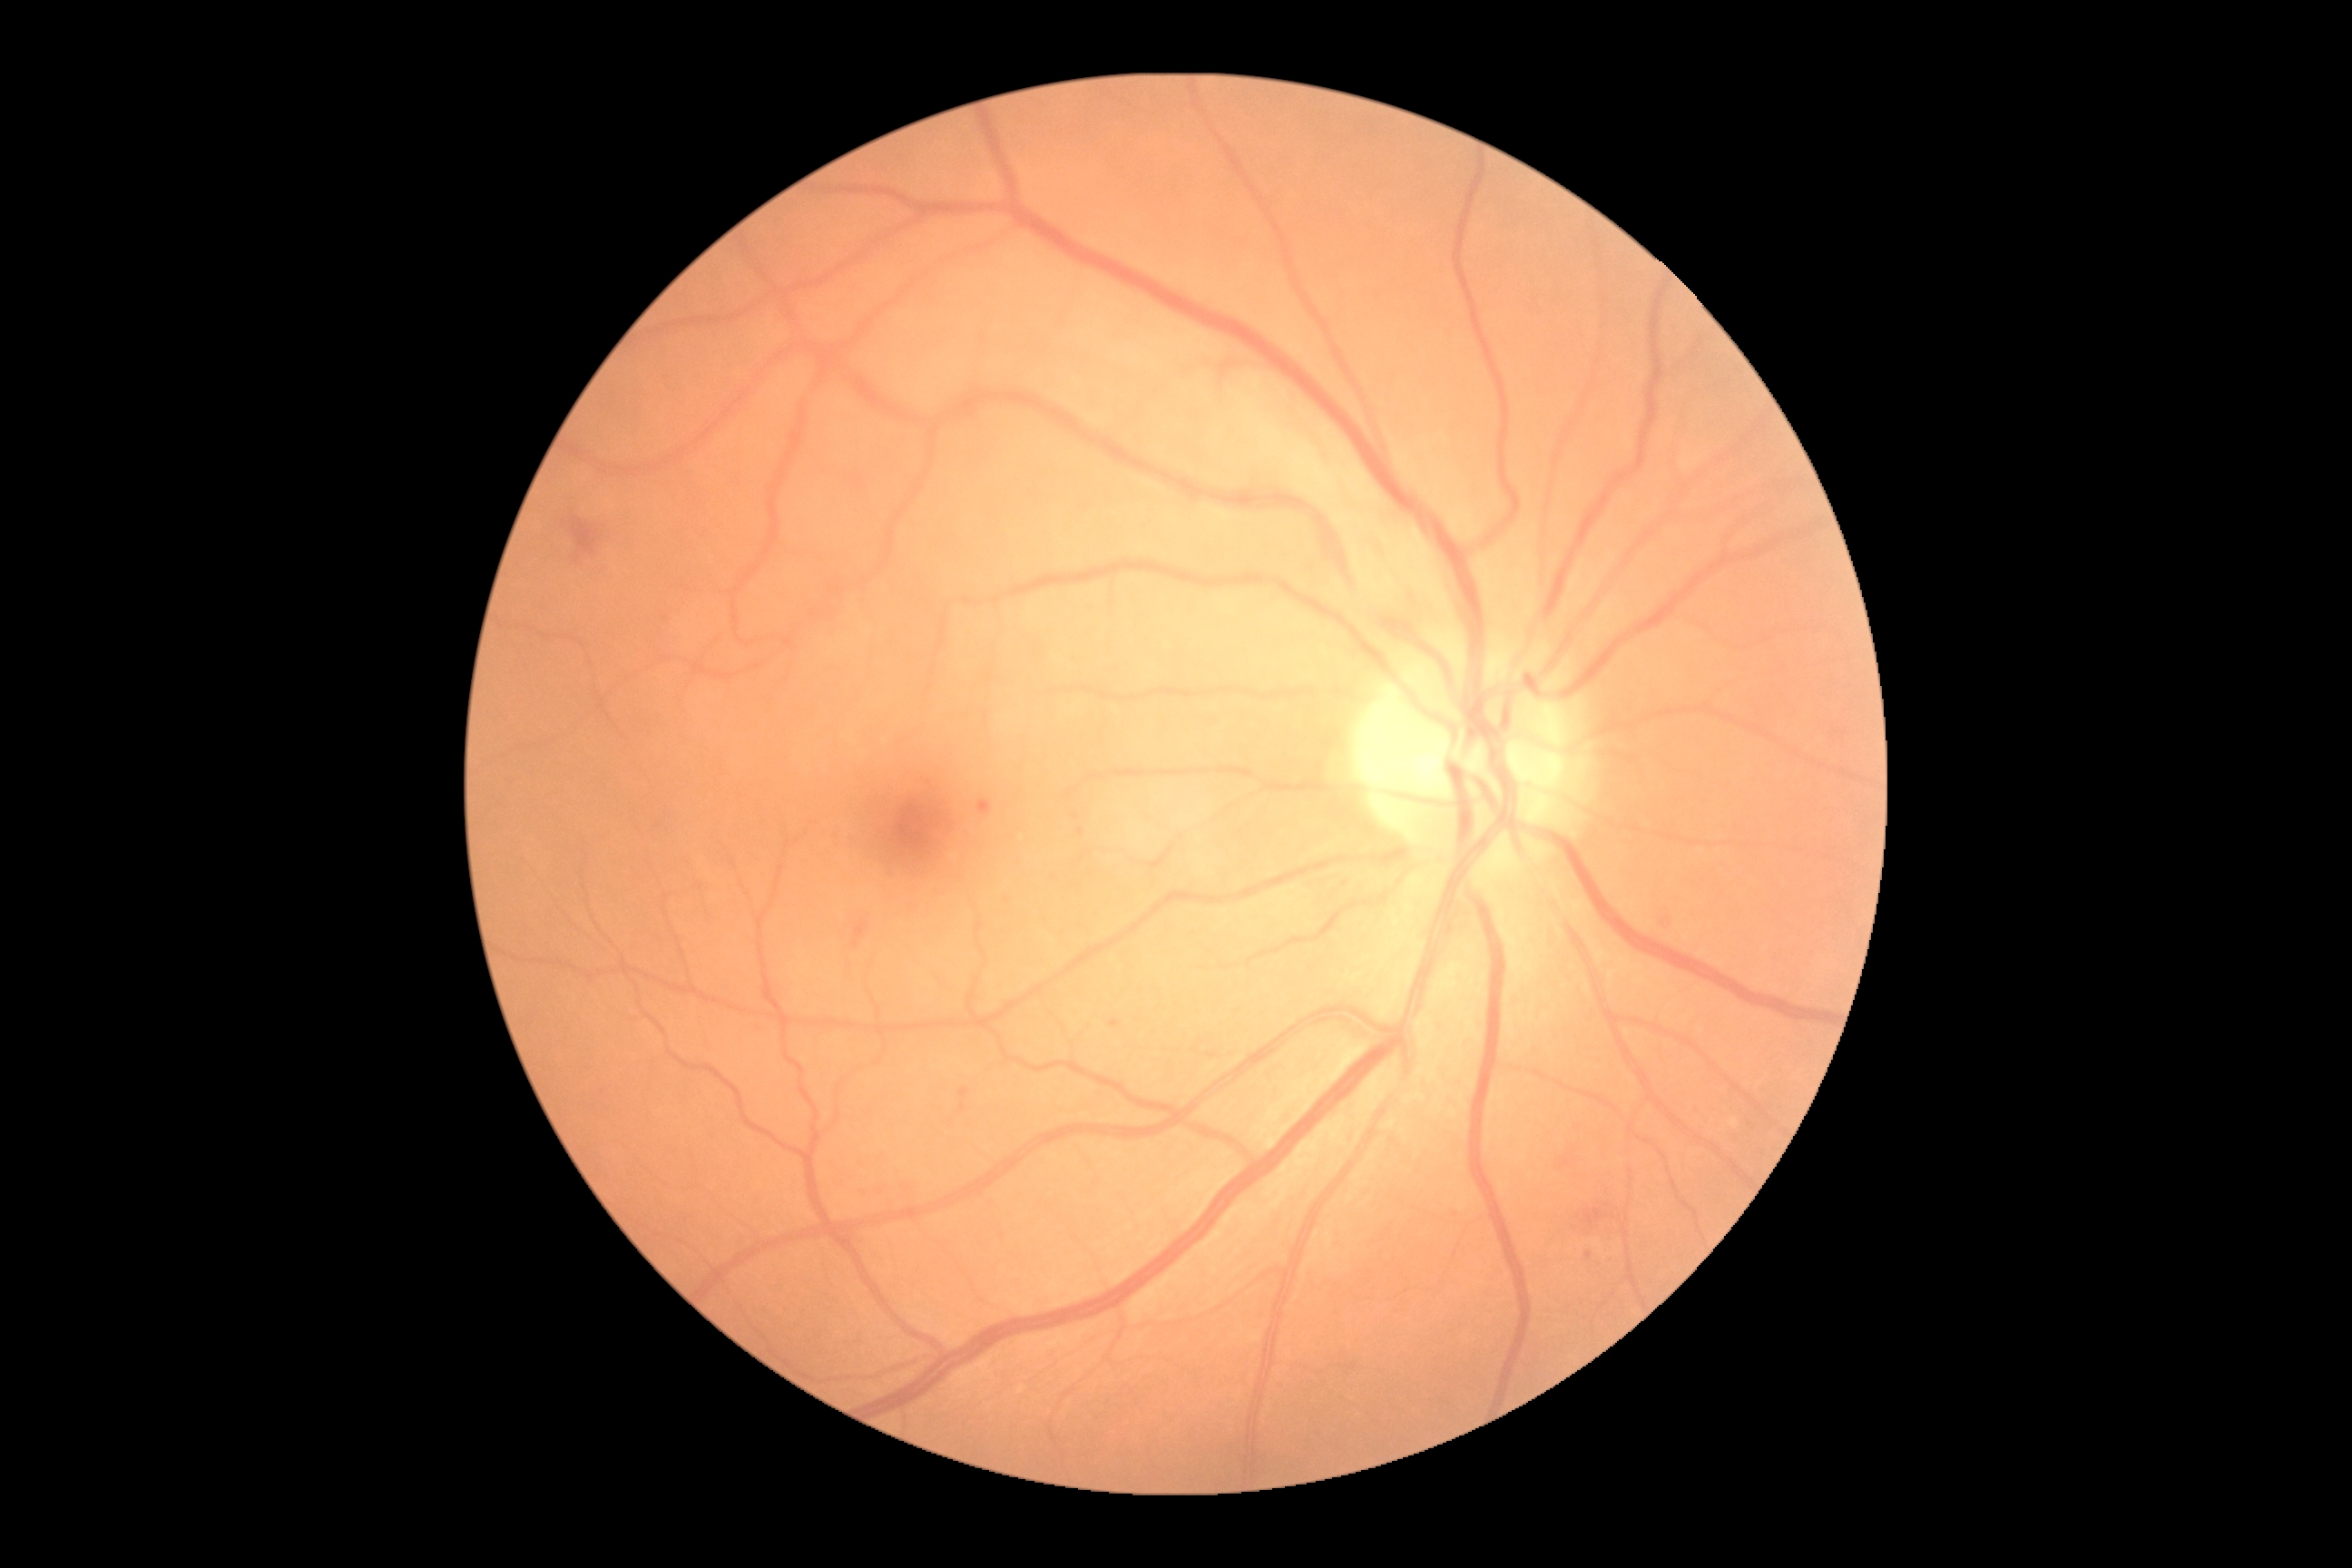 Diabetic retinopathy grade is 2.
Disease class: non-proliferative diabetic retinopathy.